100° field of view (Phoenix ICON) · pediatric wide-field fundus photograph — 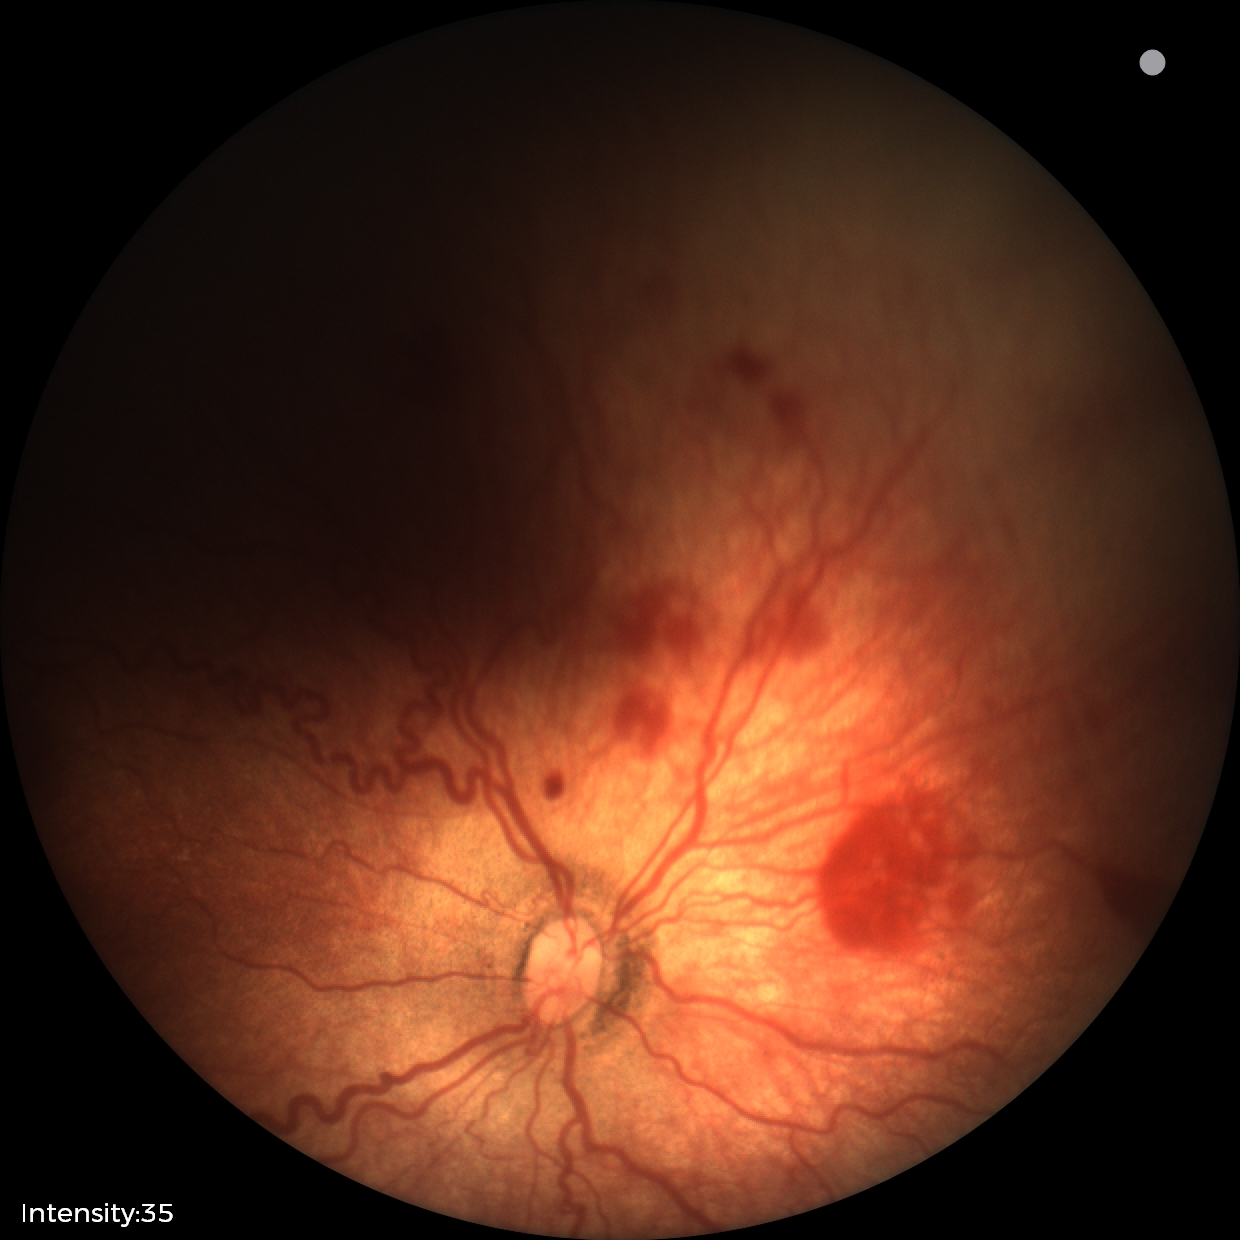 Screening examination consistent with retinopathy of prematurity stage 2. With plus disease.